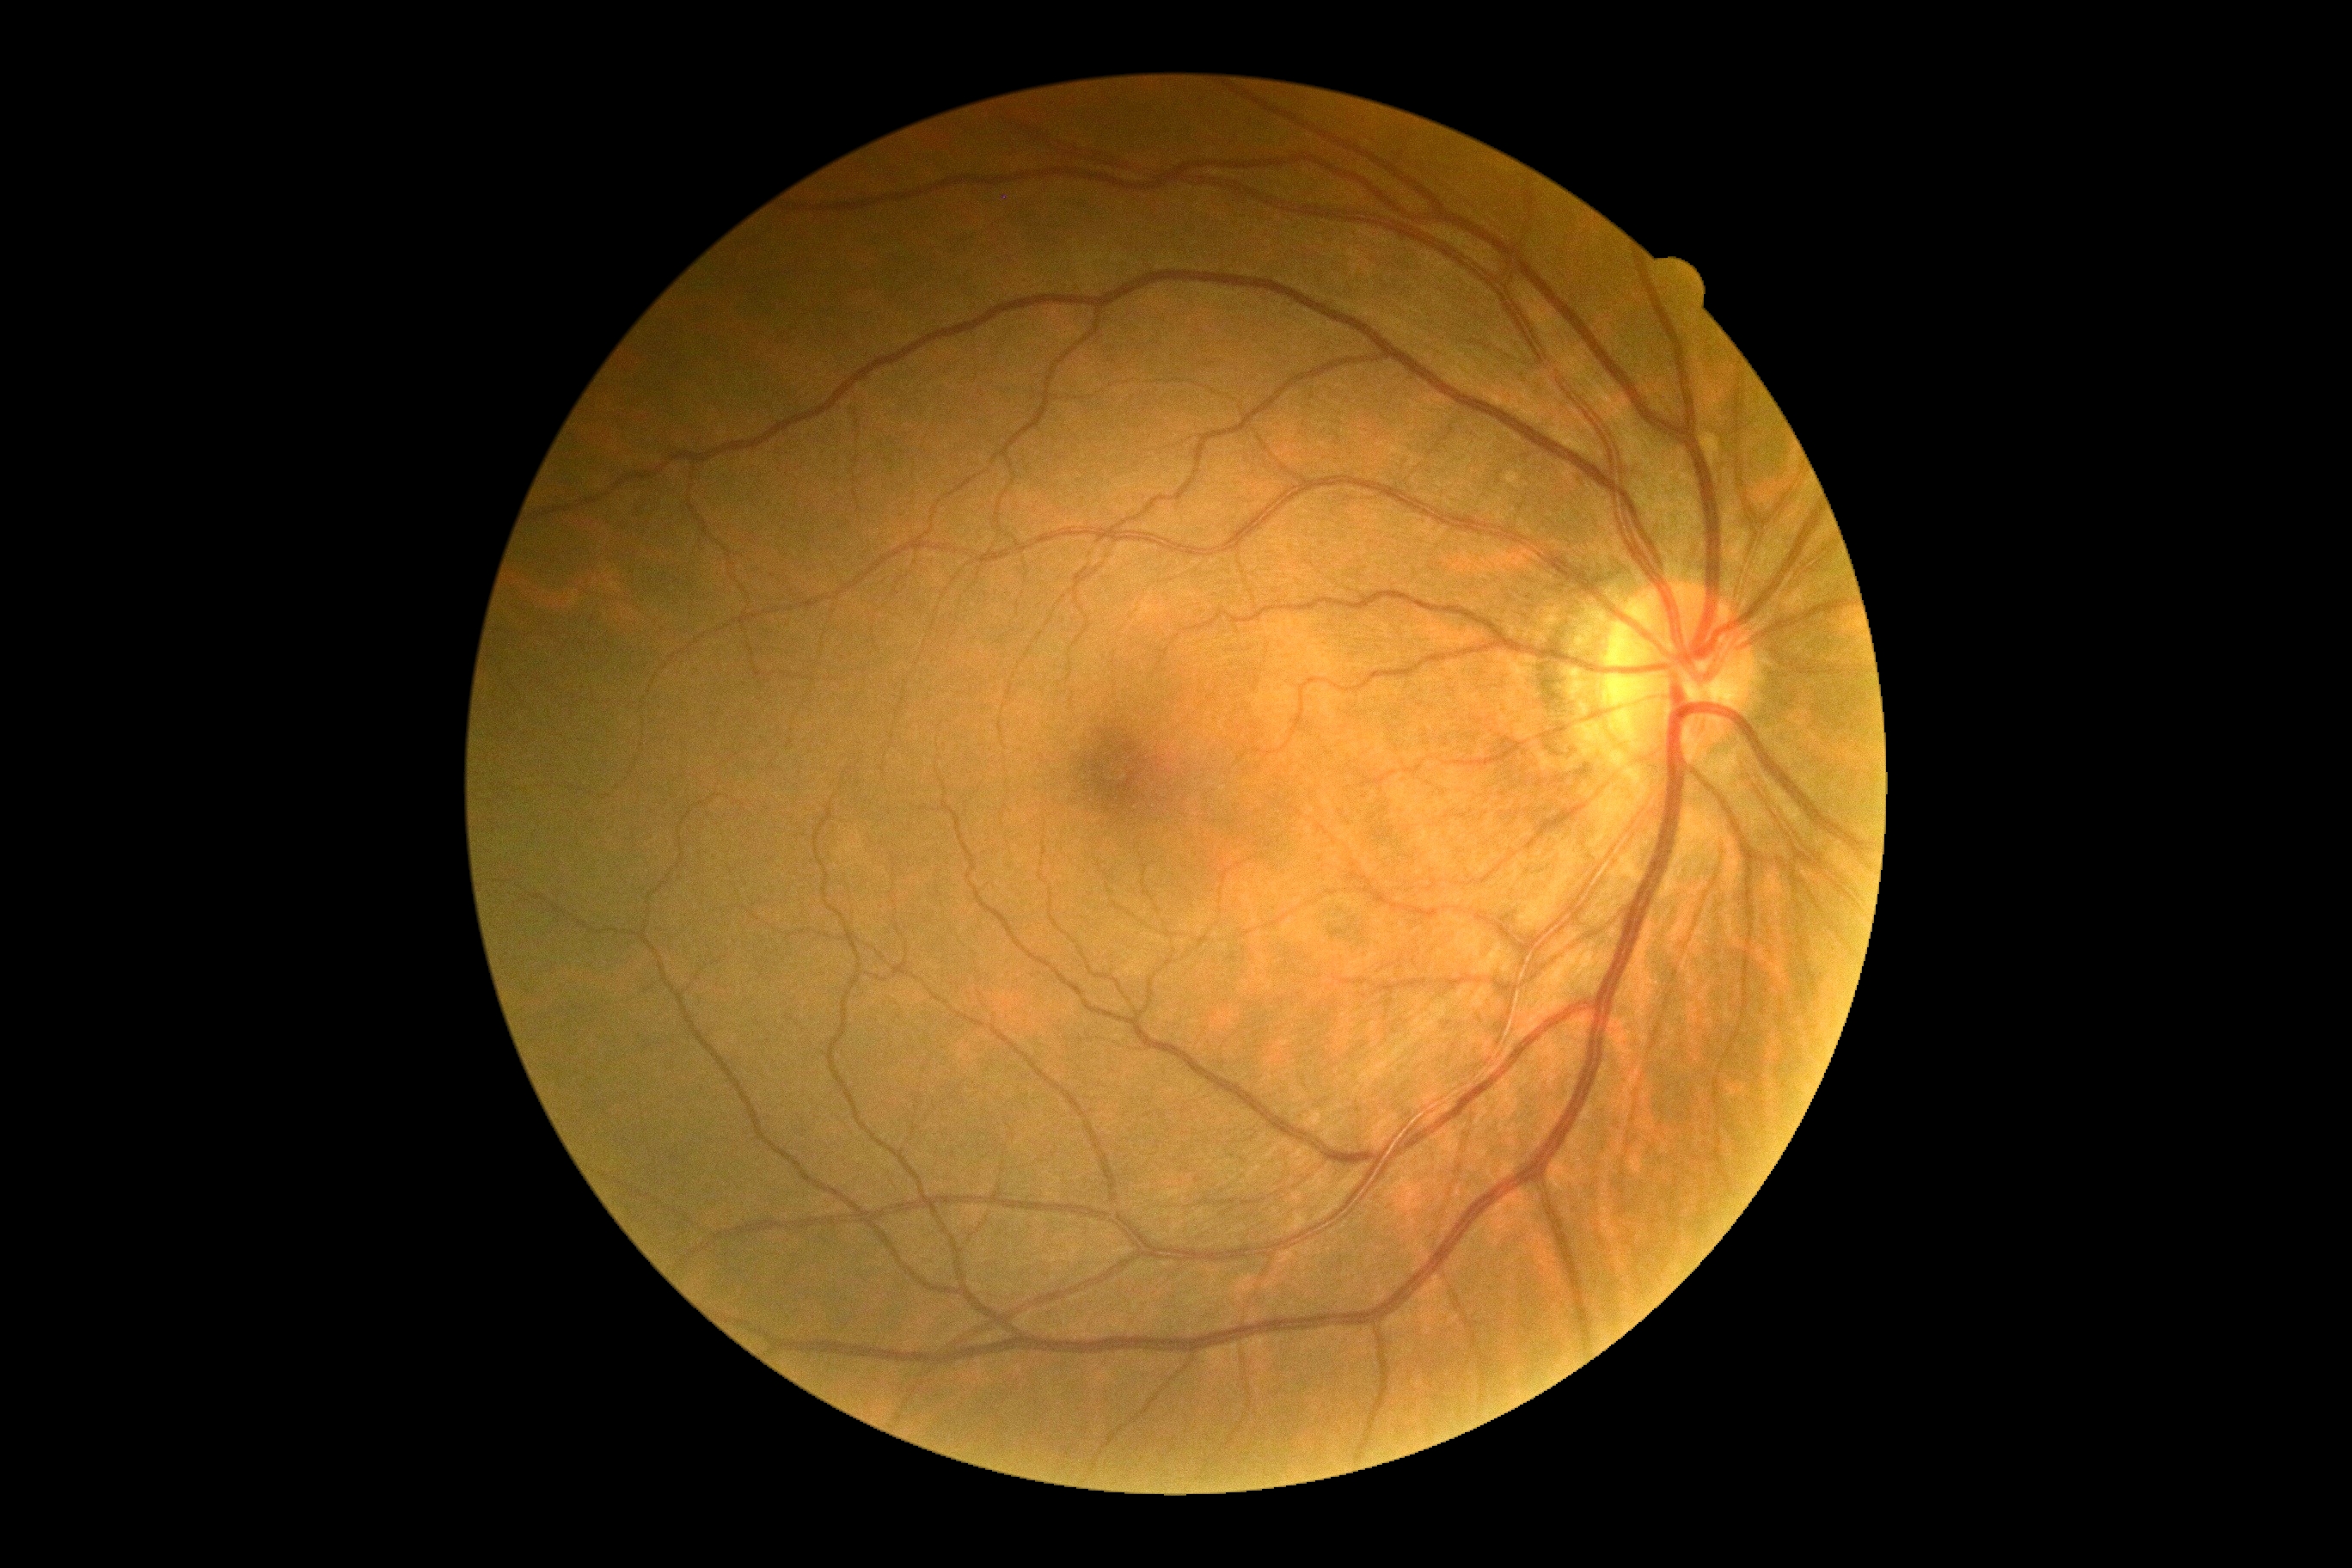 dr_grade: grade 0 — no visible signs of diabetic retinopathy